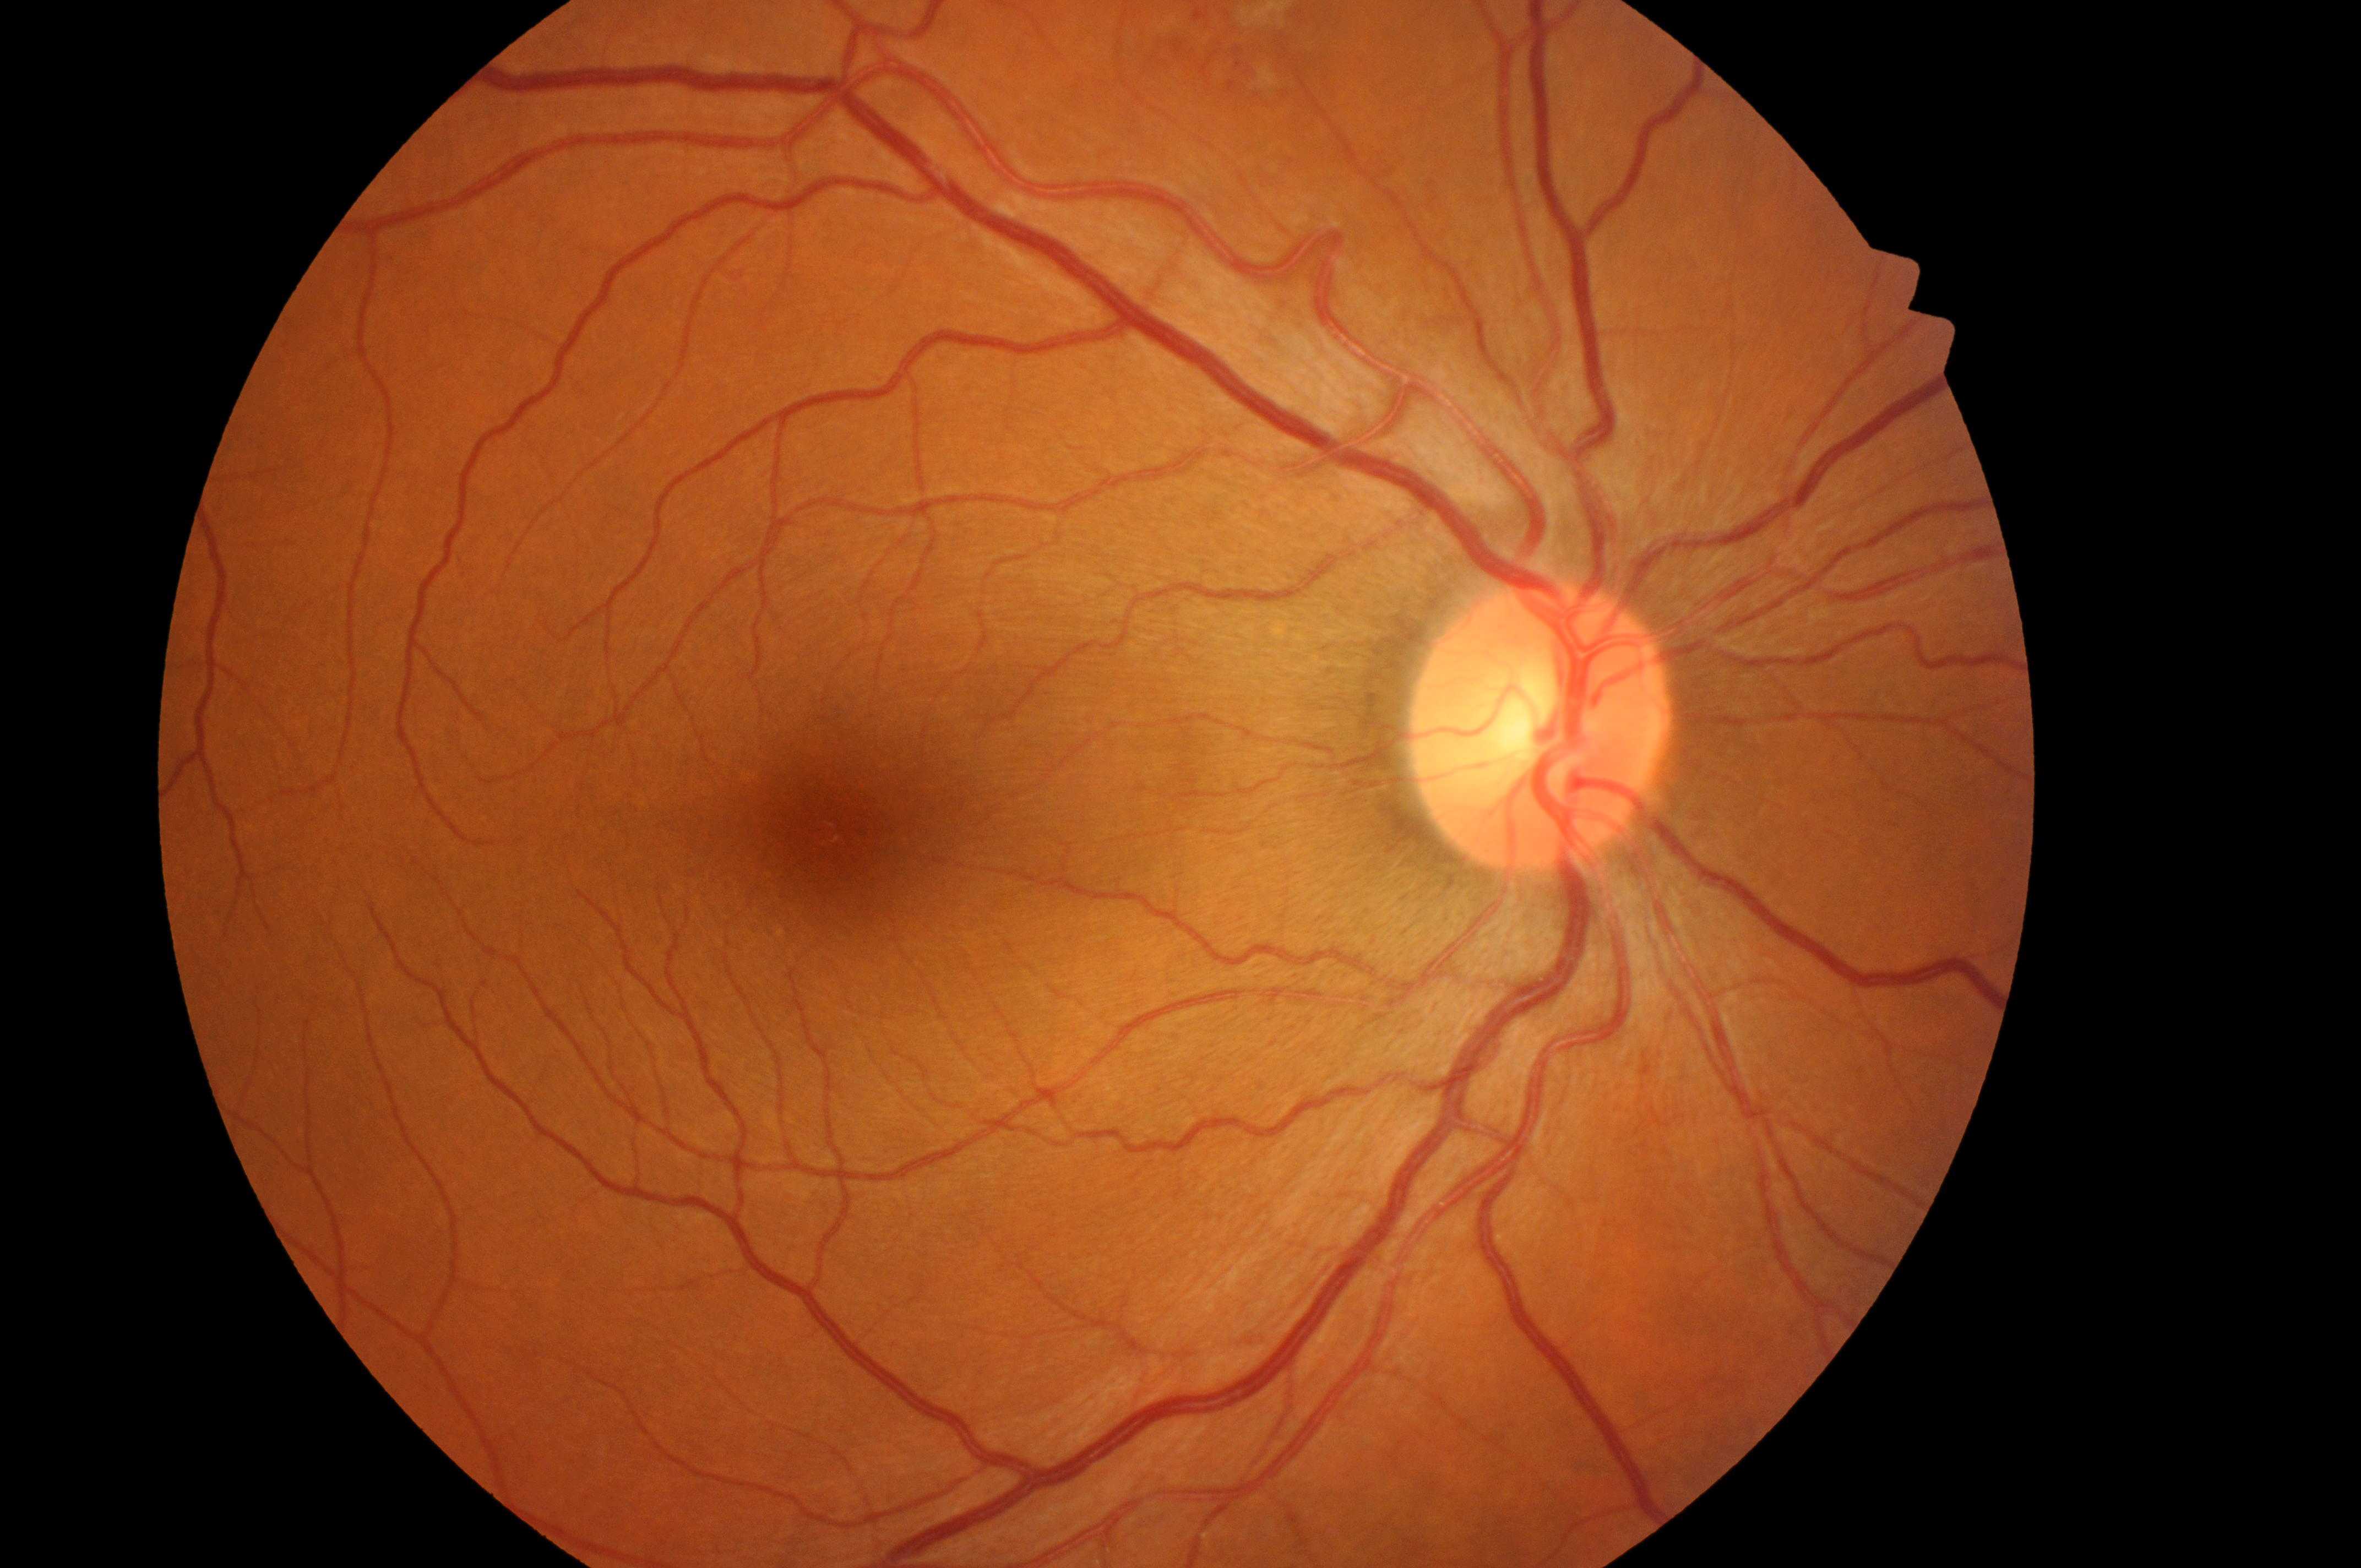

The macula center is at (x: 841, y: 837).
Diabetic retinopathy (DR) is moderate non-proliferative diabetic retinopathy (grade 2) — more than just microaneurysms but less than severe NPDR.
ONH located at (x: 1532, y: 734).
Eye: the right eye.
Diabetic macular edema (DME) is no risk (grade 0) — no apparent hard exudates.